DR severity per modified Davis staging. 45-degree field of view. Acquired with a NIDEK AFC-230:
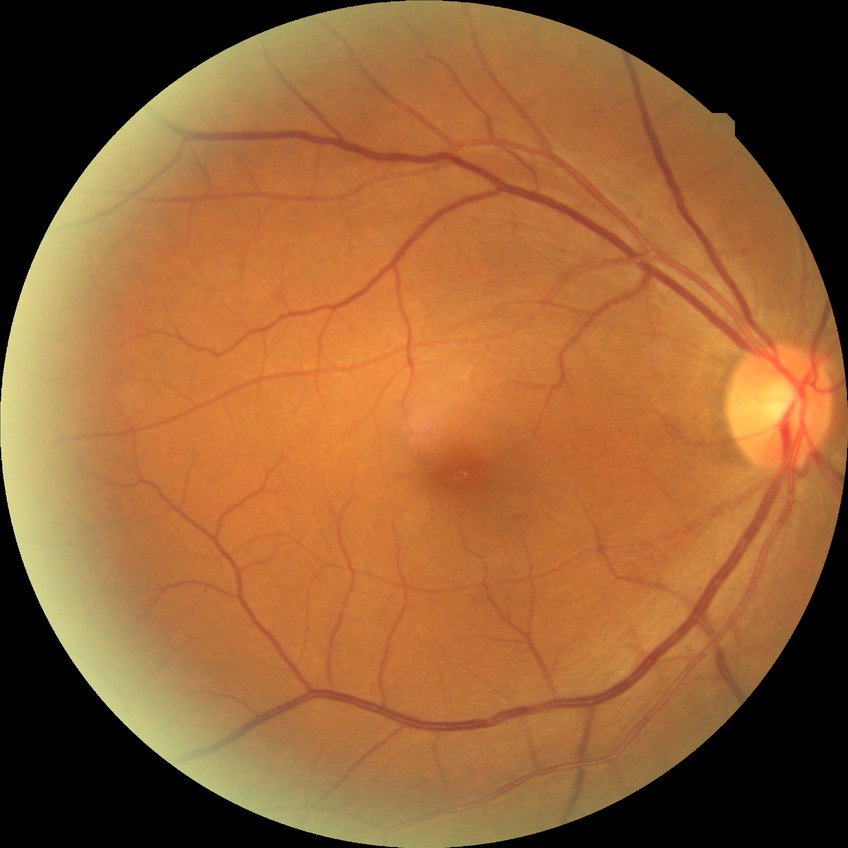 DR is NDR. No DR findings.